Acquired with a Nidek AFC-330. Optic nerve head crop. Retinal fundus photograph: 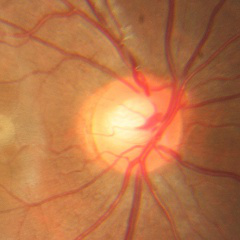

Demonstrates no glaucomatous changes.